DR severity per modified Davis staging
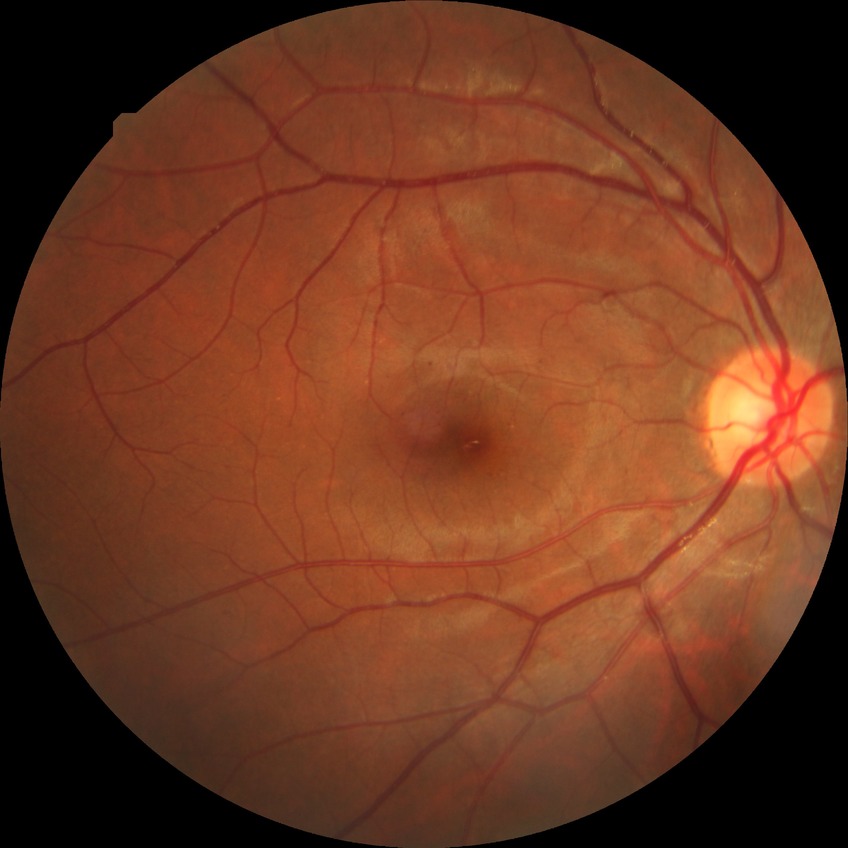

davis_grade: simple diabetic retinopathy